Fundus photo; 2048 by 1536 pixels: 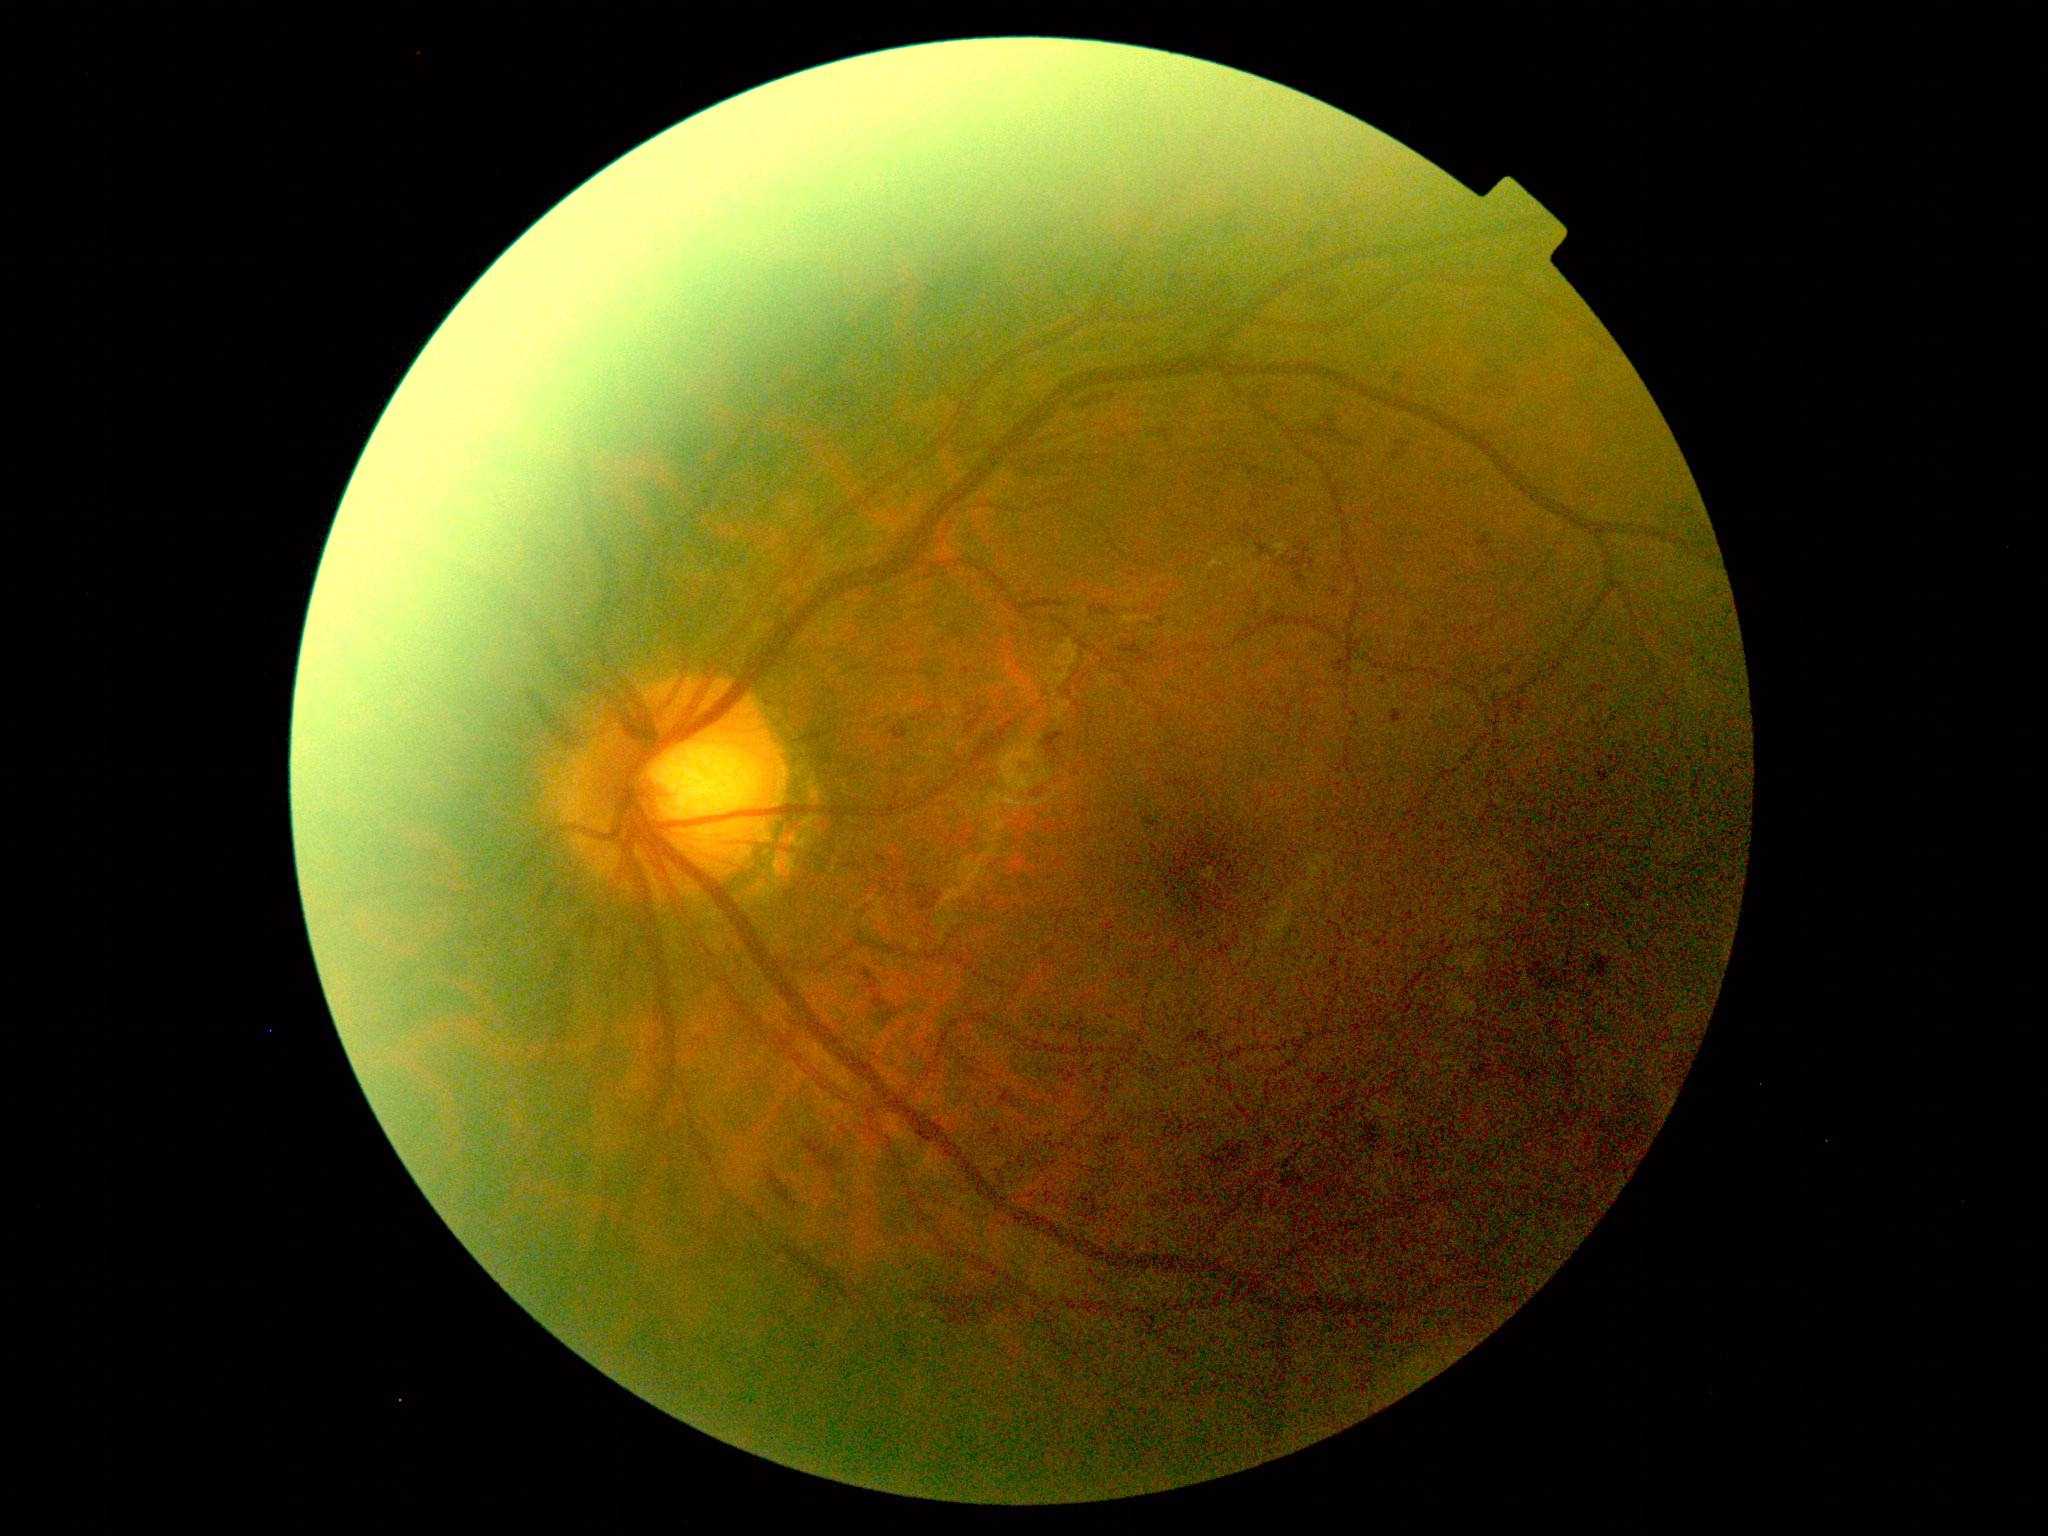

DR grade: 2.